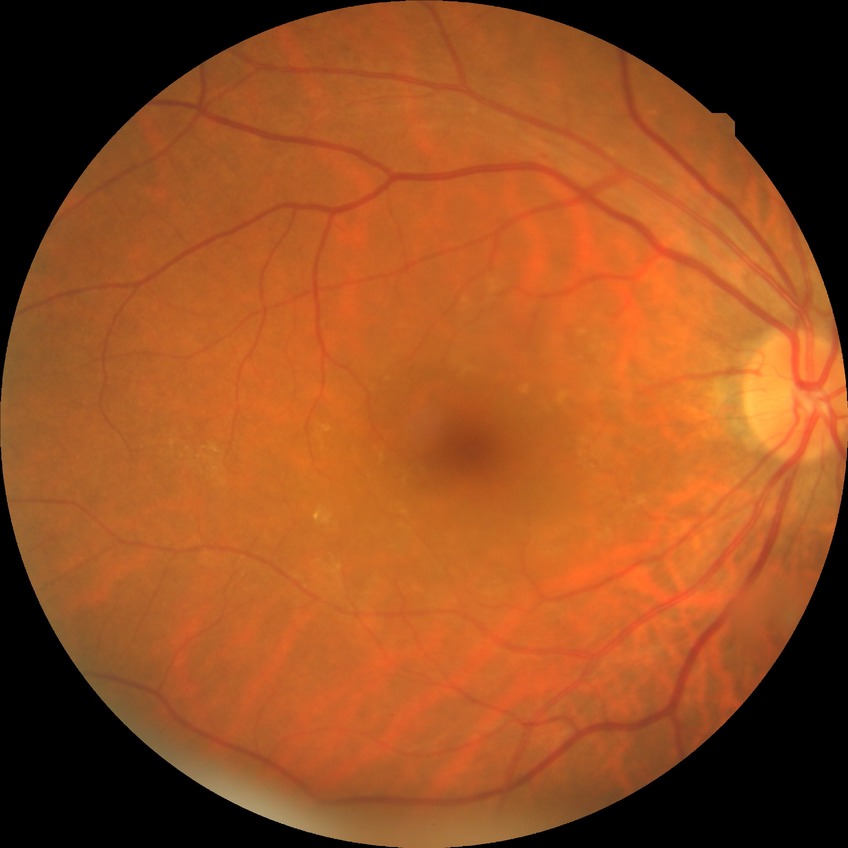

{
  "davis_grade": "no diabetic retinopathy"
}